Ultra-widefield fundus mosaic:
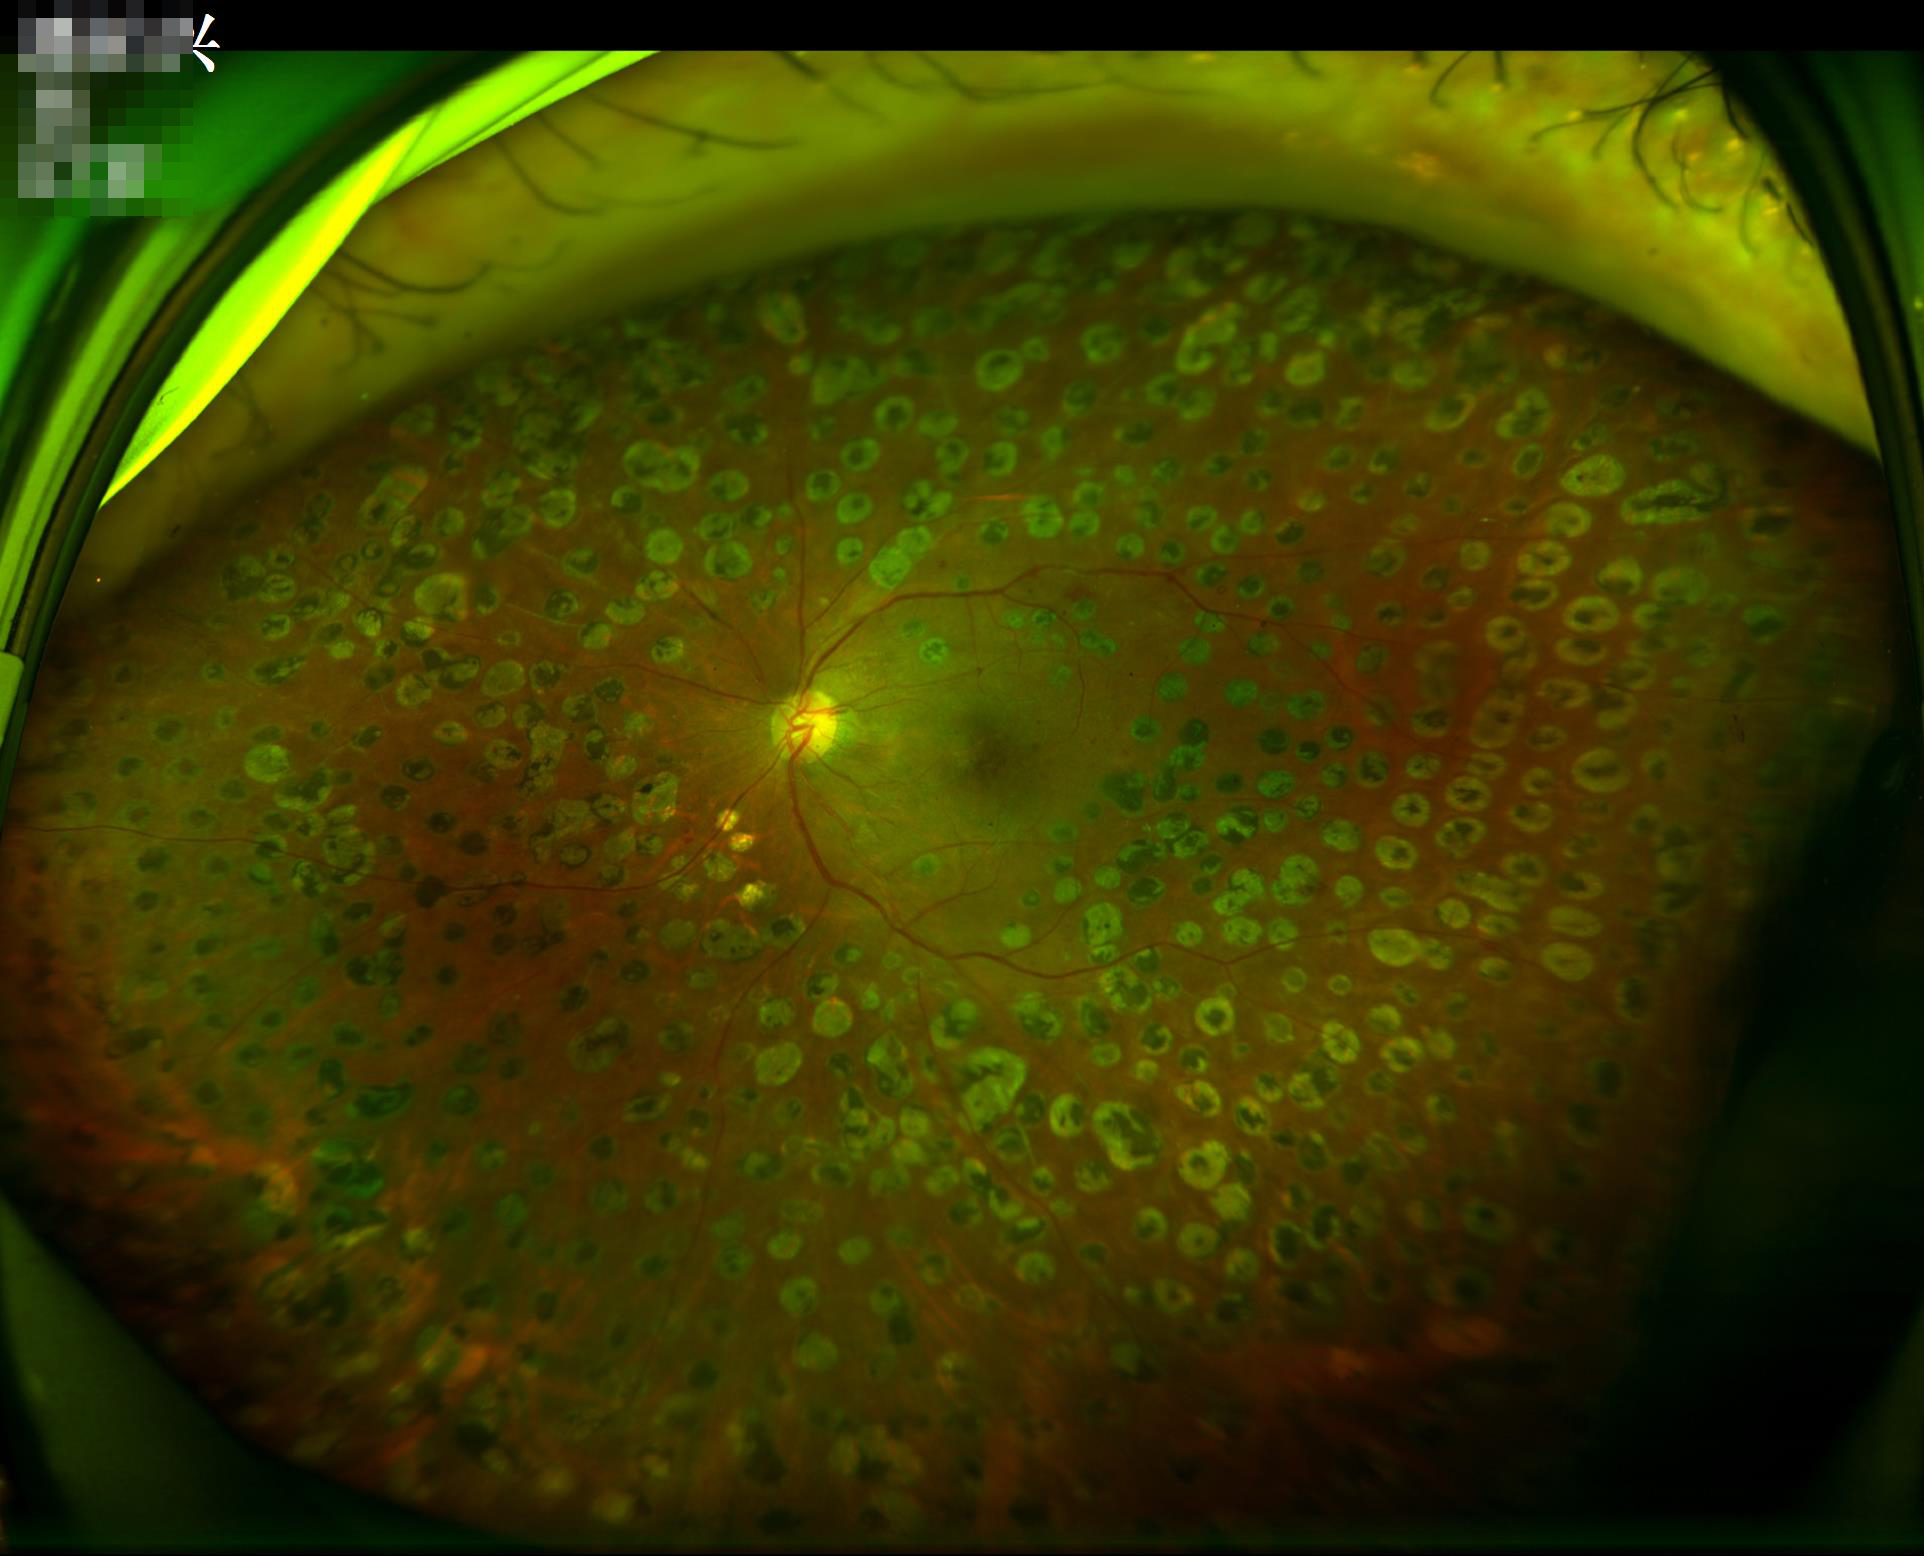
Contrast = adequate; Overall image quality = satisfactory; Clarity = in focus.